2346x1568px, color fundus photograph.
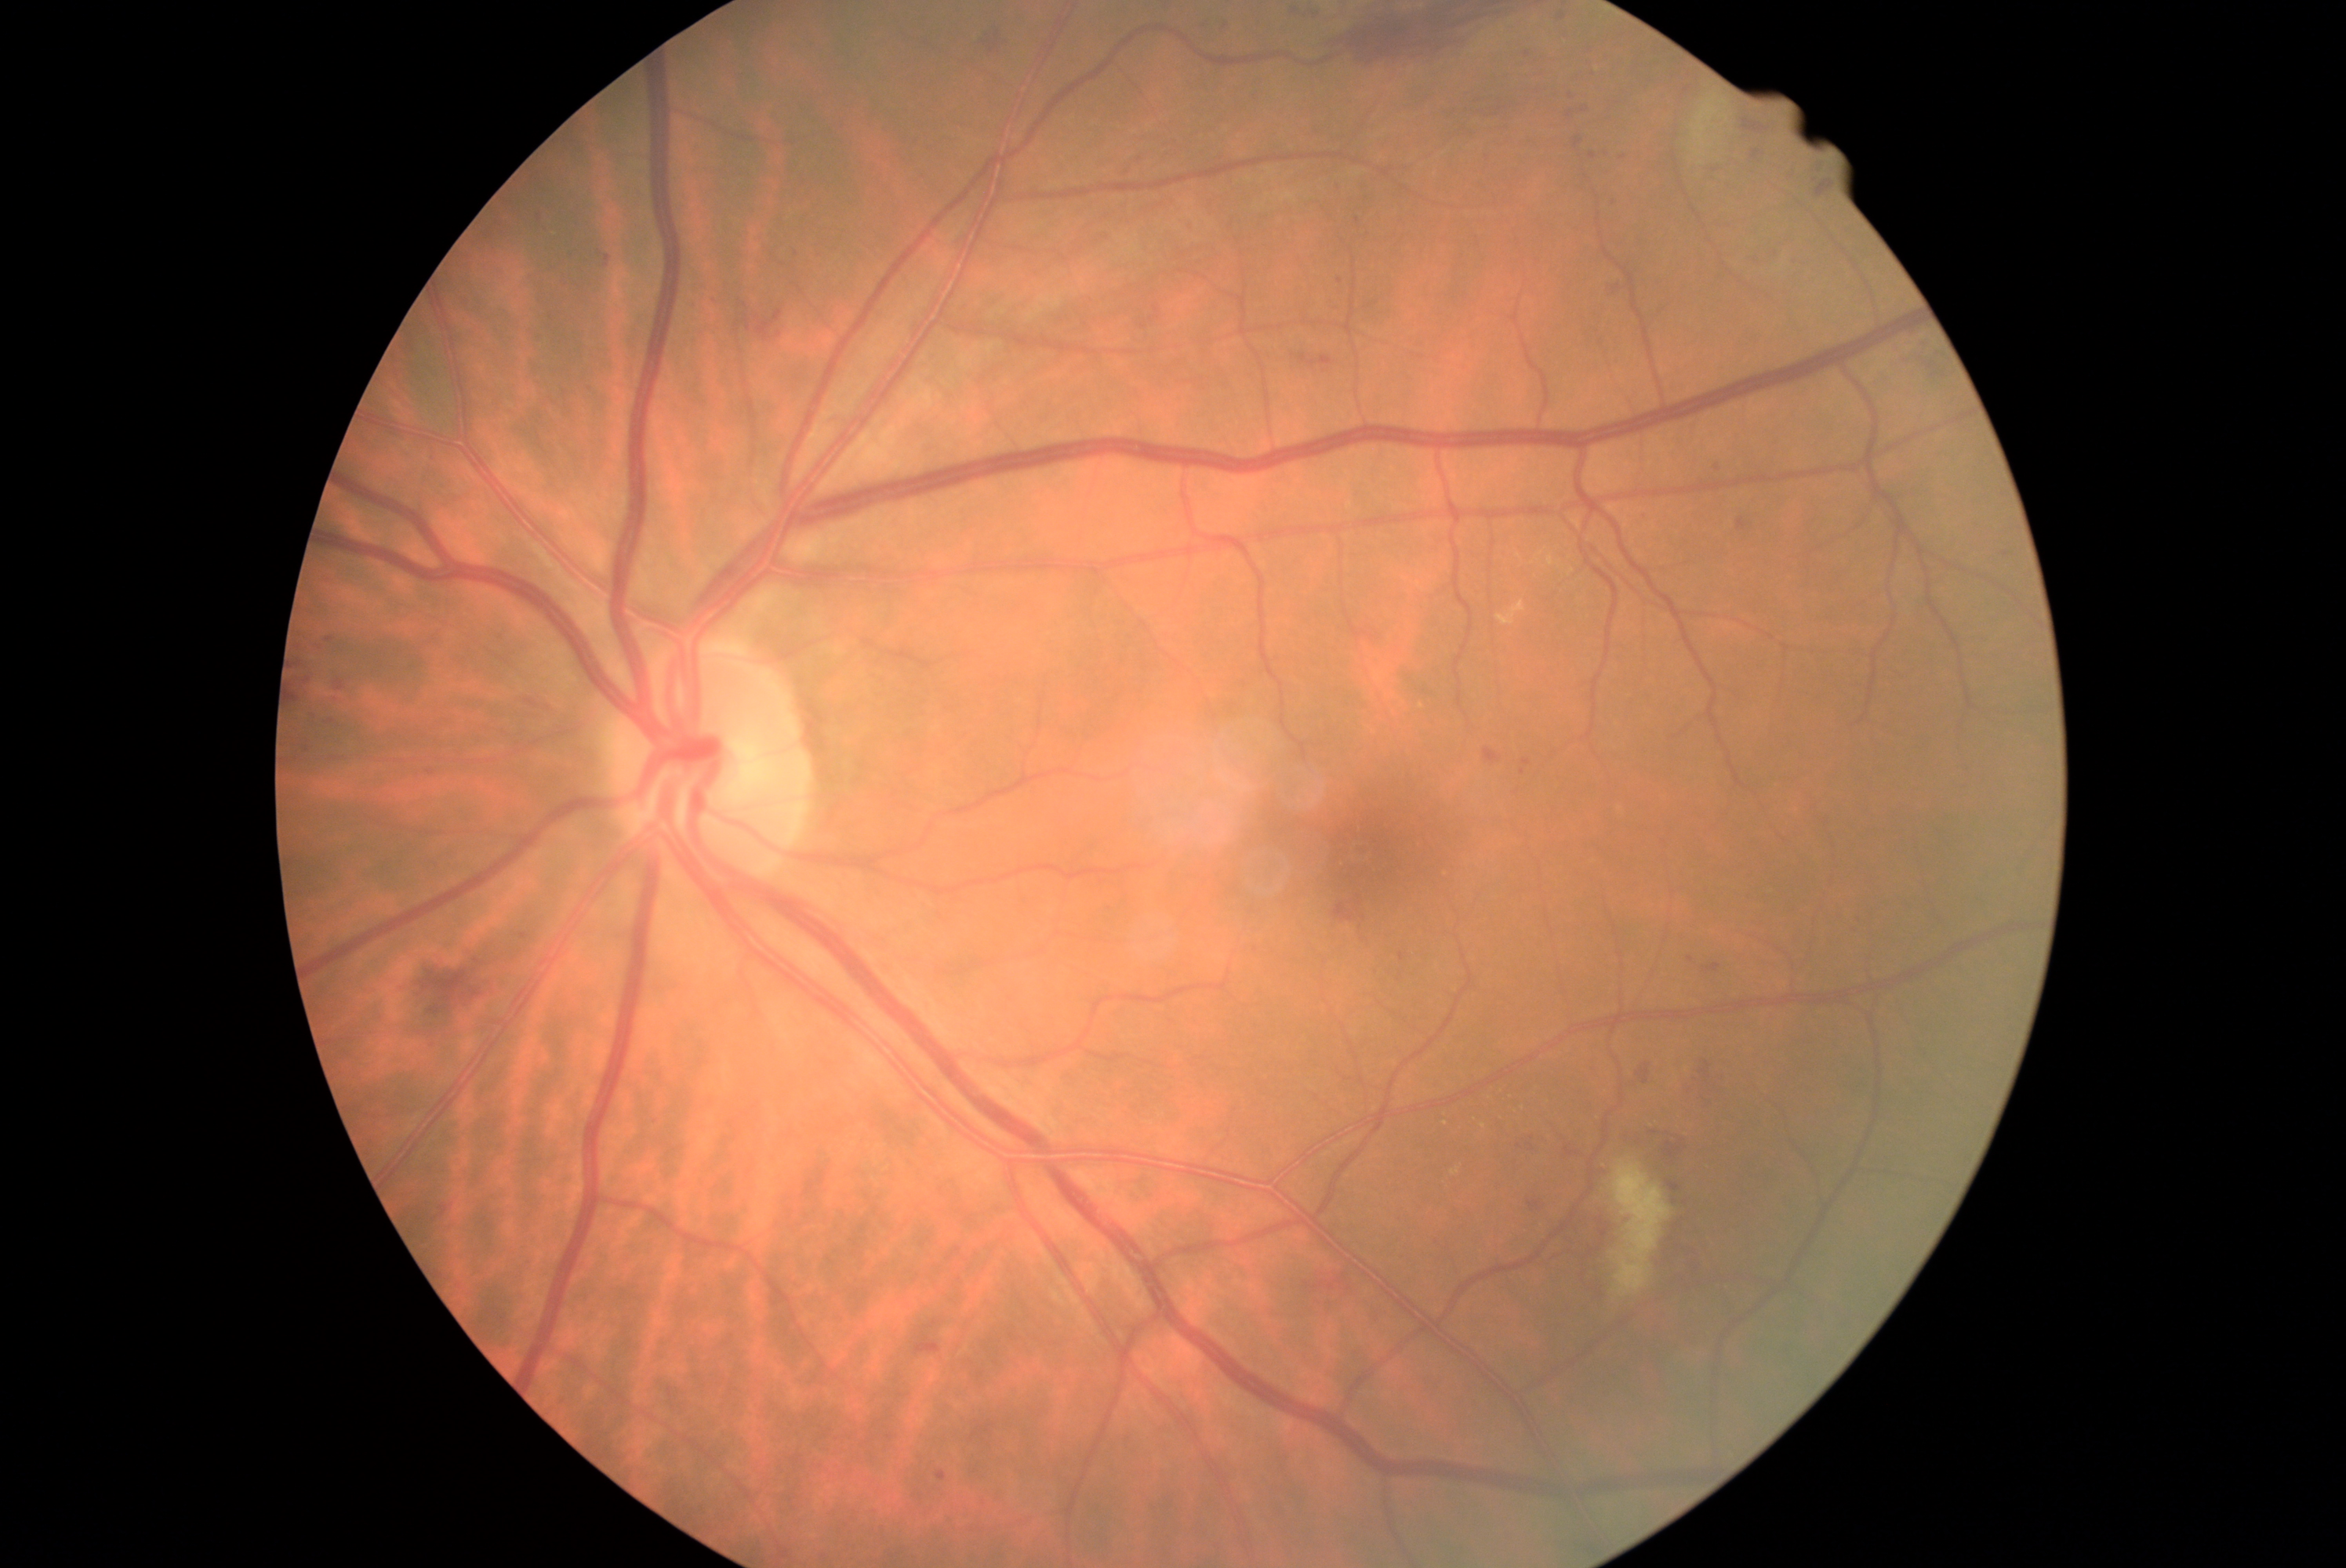

Diabetic retinopathy (DR): 2/4
Selected lesions:
hard exudates (EXs) (continued): 1498:603:1527:625 | 1451:1169:1459:1177
Small EXs approximately at (1484, 1127) | (1446, 1125)
microaneurysms (MAs) (continued): 303:678:311:684 | 1854:910:1862:921 | 427:1037:437:1044 | 1636:1130:1655:1144 | 520:934:528:940 | 1287:9:1296:20 | 1715:465:1721:473 | 1749:258:1757:263 | 1218:26:1226:37 | 1847:926:1859:935 | 1523:760:1531:768
Small MAs approximately at (2007, 554) | (1711, 172) | (1570, 115) | (540, 218)
hemorrhages (HEs) (continued): 1655:1141:1687:1158 | 528:700:537:708 | 1668:1222:1699:1272 | 292:683:302:706 | 1616:283:1627:302 | 1353:7:1508:67 | 1306:1276:1346:1291 | 915:1337:942:1356 | 755:310:783:341 | 1564:1149:1578:1158 | 1817:181:1836:198 | 1636:1065:1651:1086 | 1743:118:1767:132 | 978:37:1001:54
Small HEs approximately at (780, 335)
soft exudates (SEs): 1608:1160:1671:1298 | 1691:93:1730:173